2048 by 1536 pixels · 45-degree field of view:
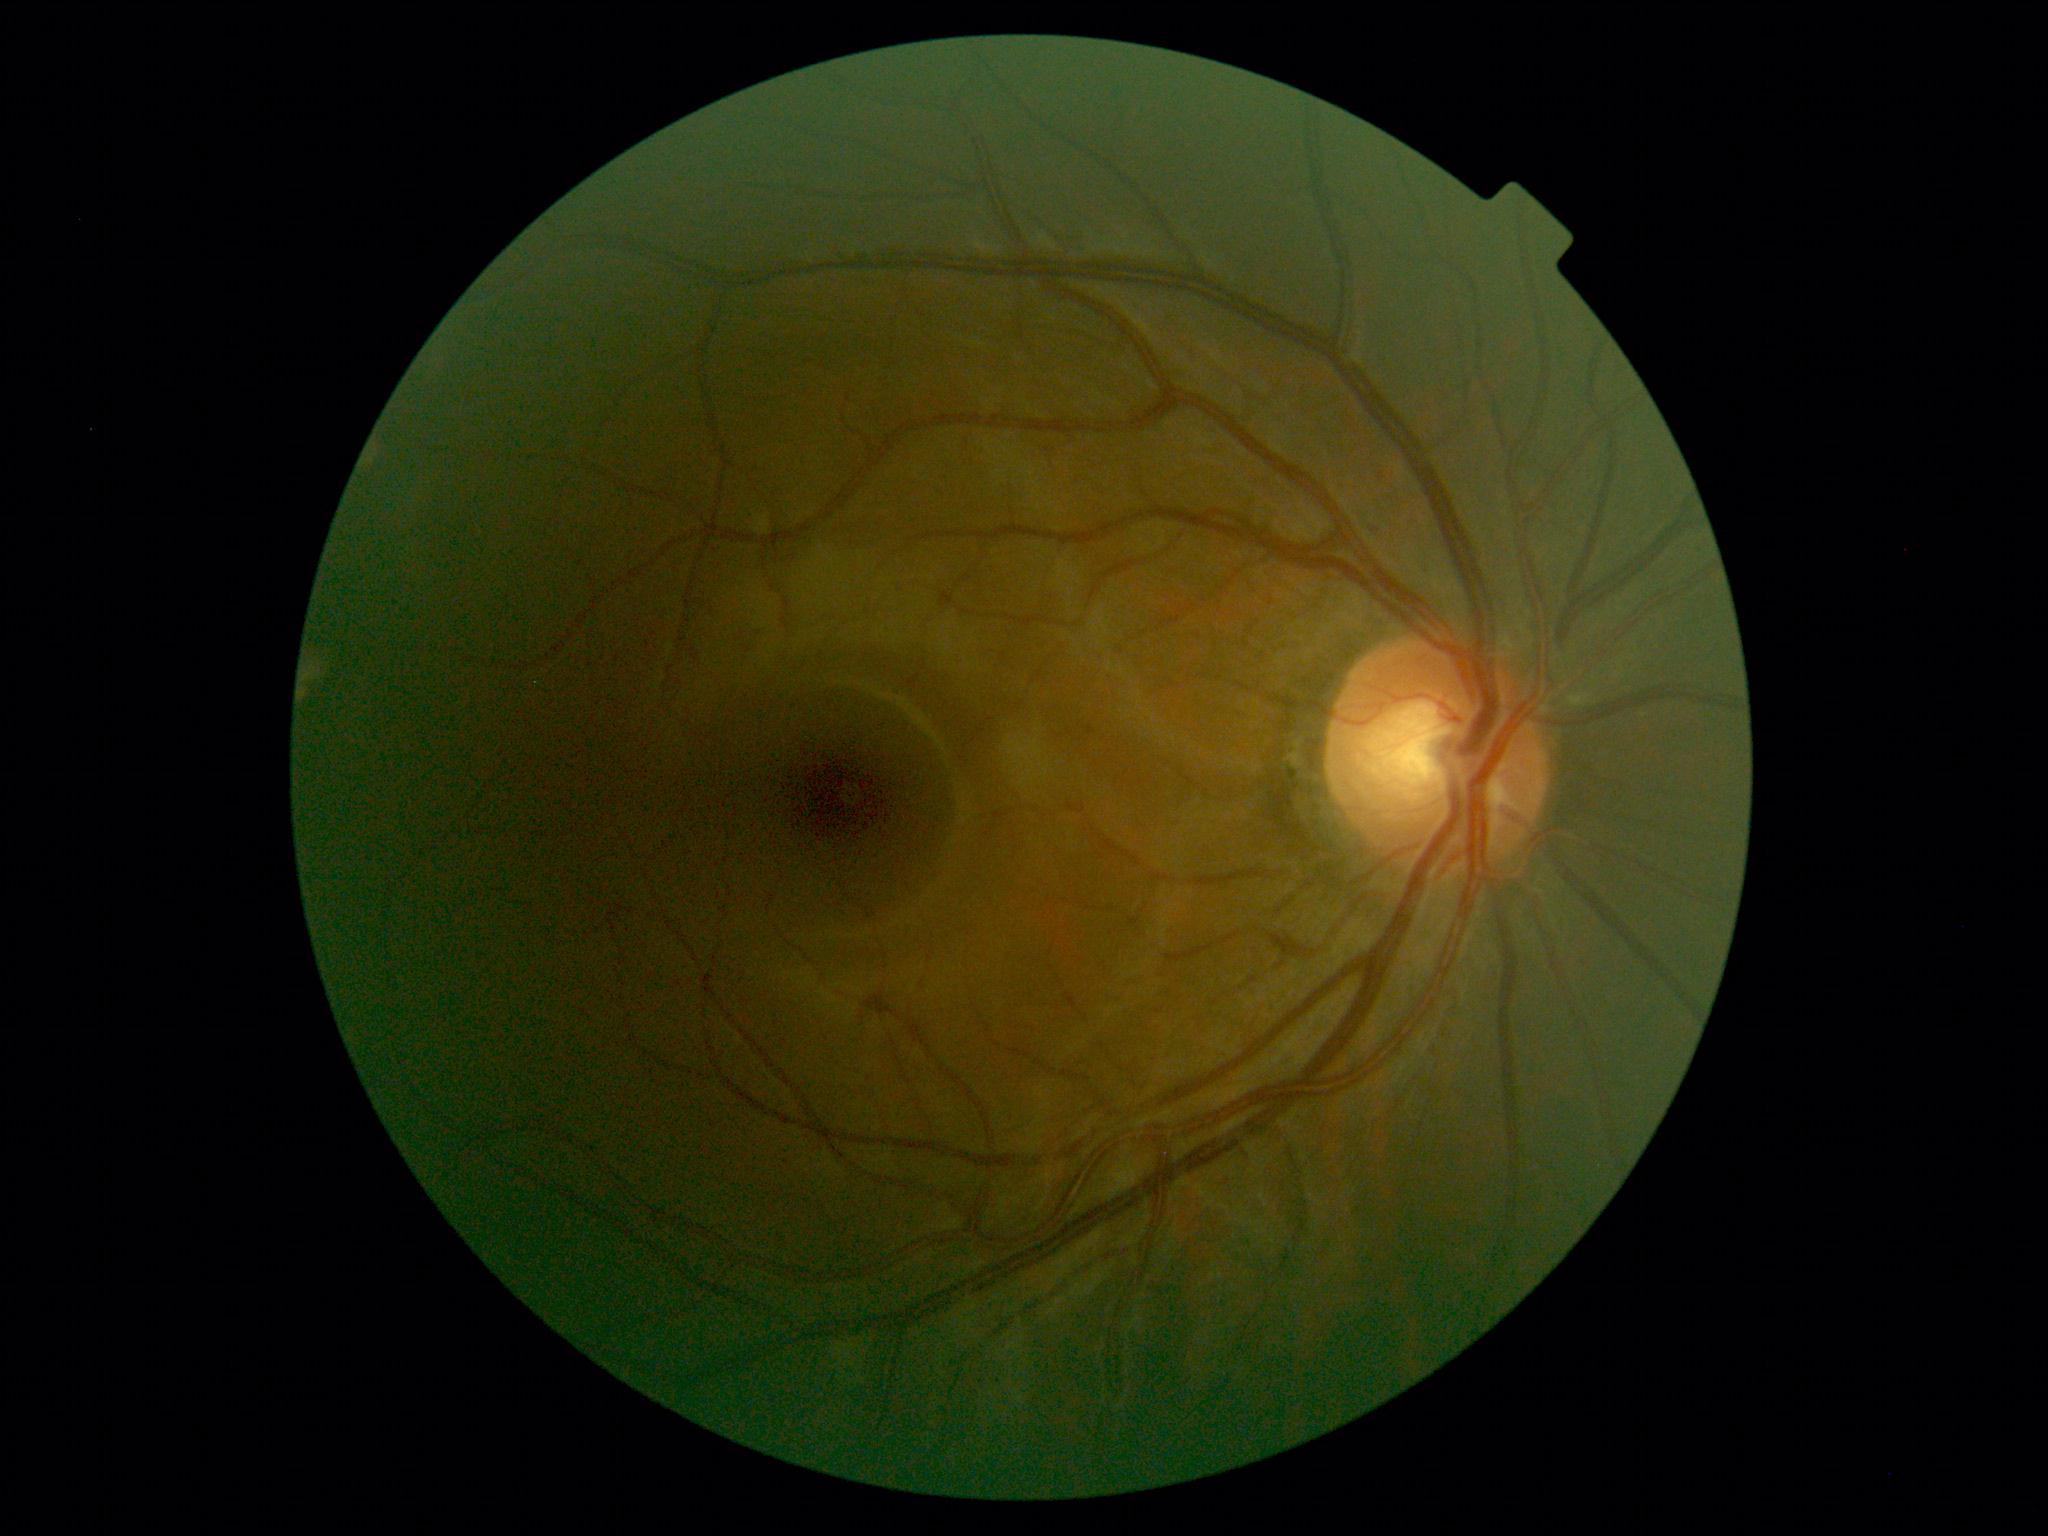 DR stage: grade 0 (no apparent retinopathy) — no visible signs of diabetic retinopathy.